2048 by 1536 pixels; 45° FOV; color fundus photograph — 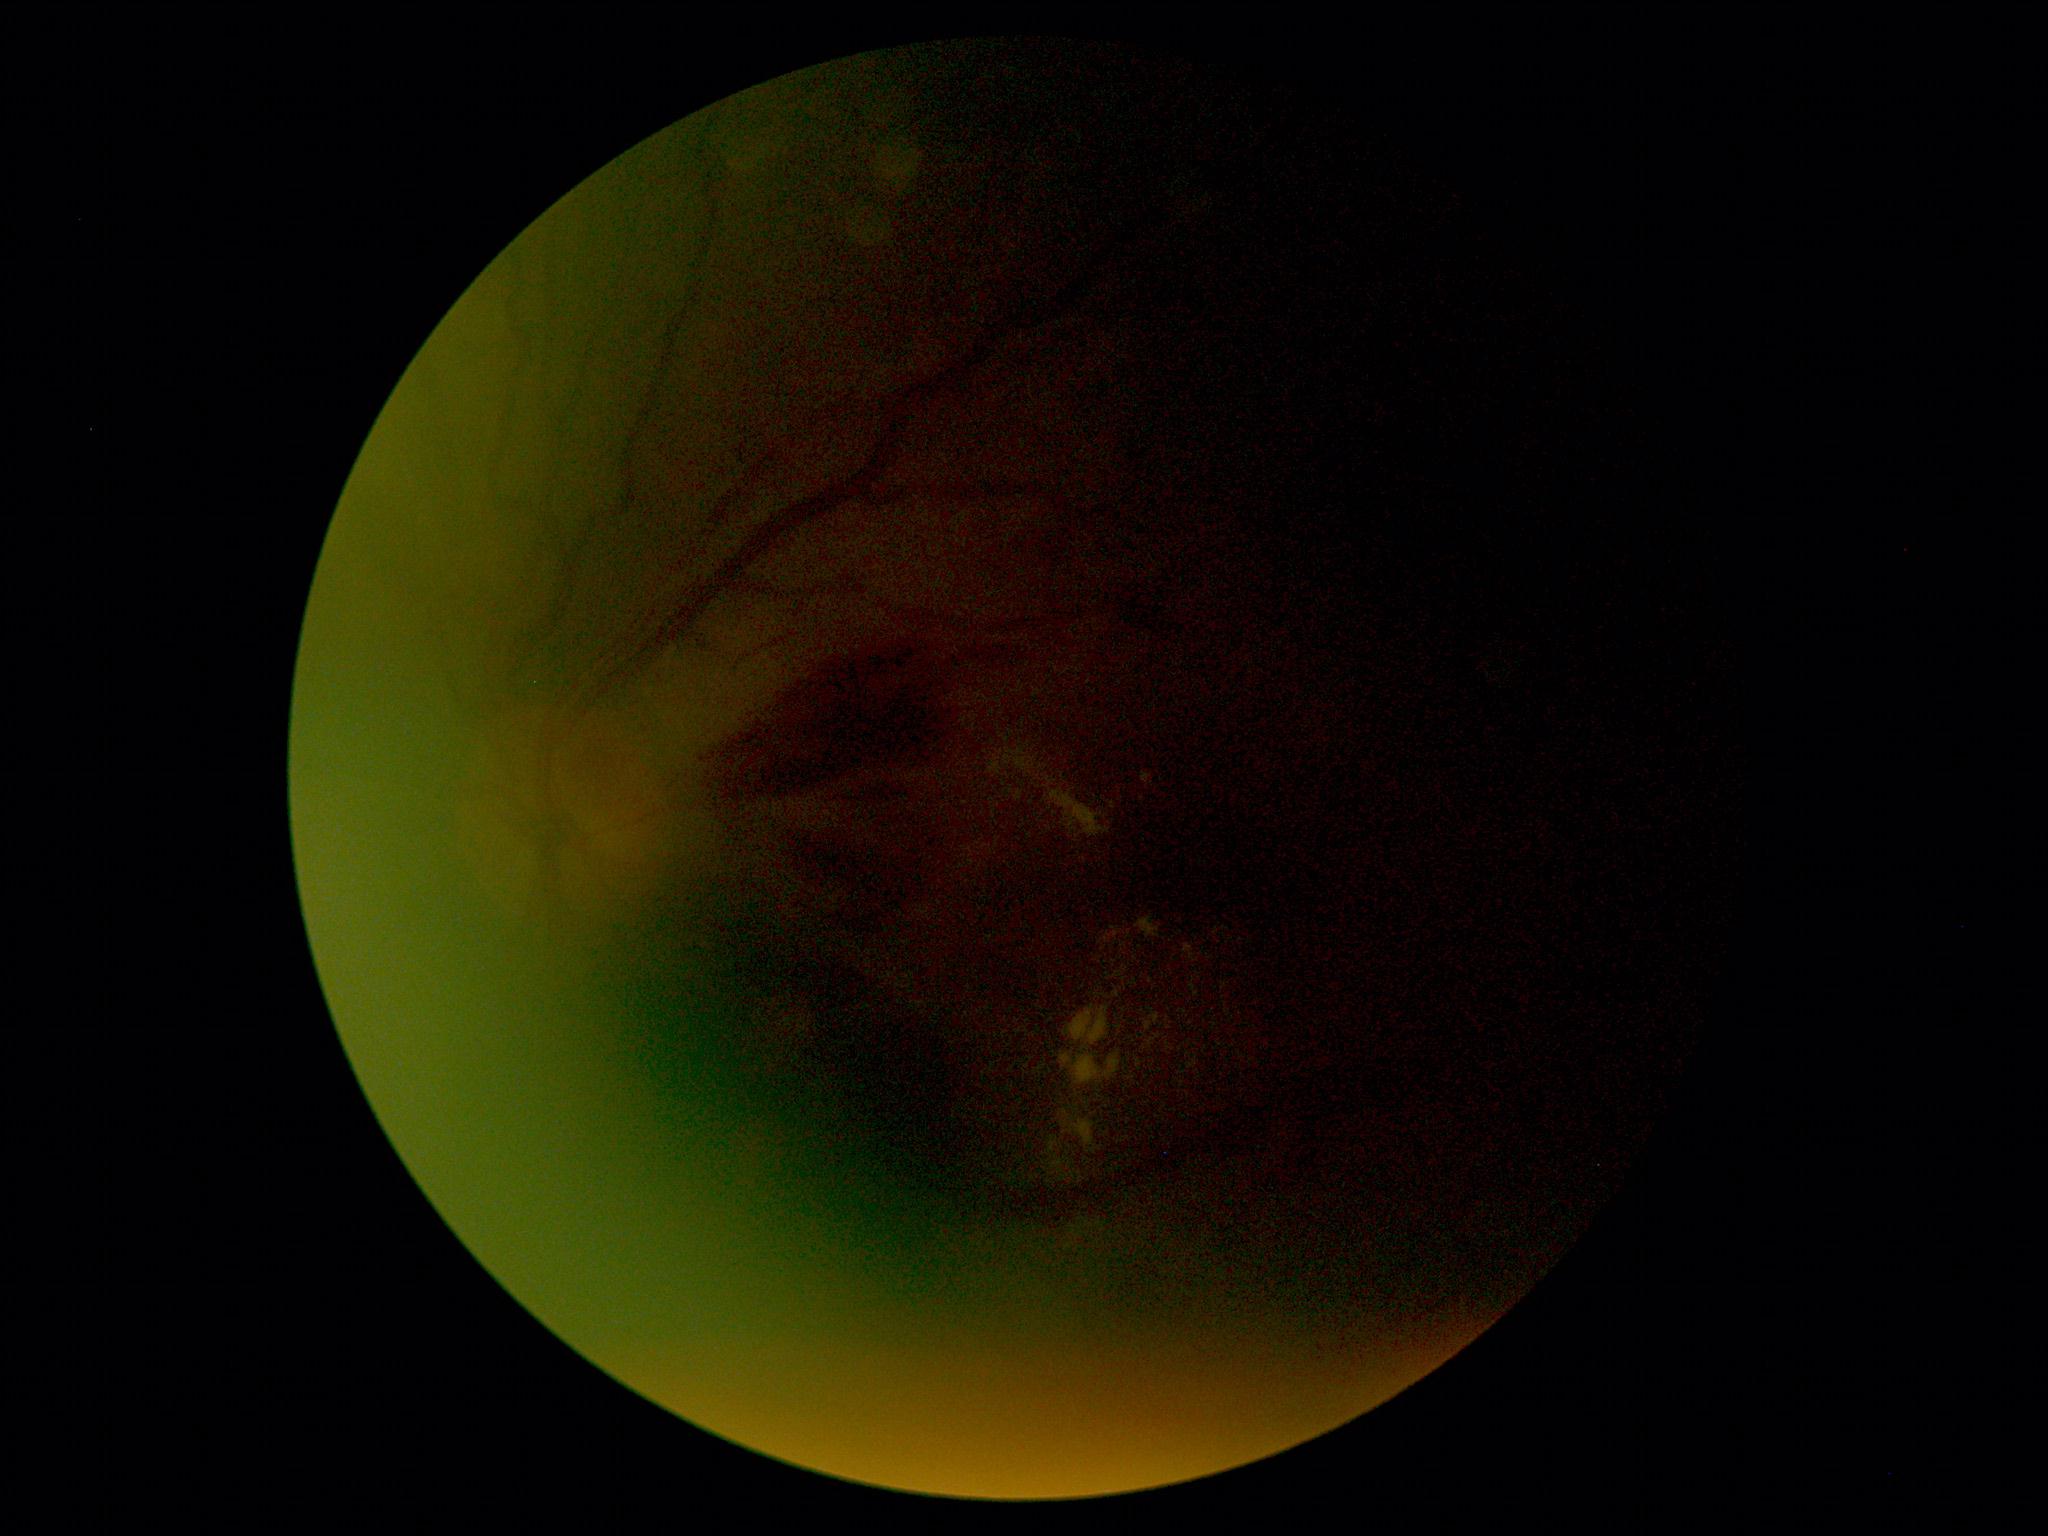
DR grade is 2.